CFP: 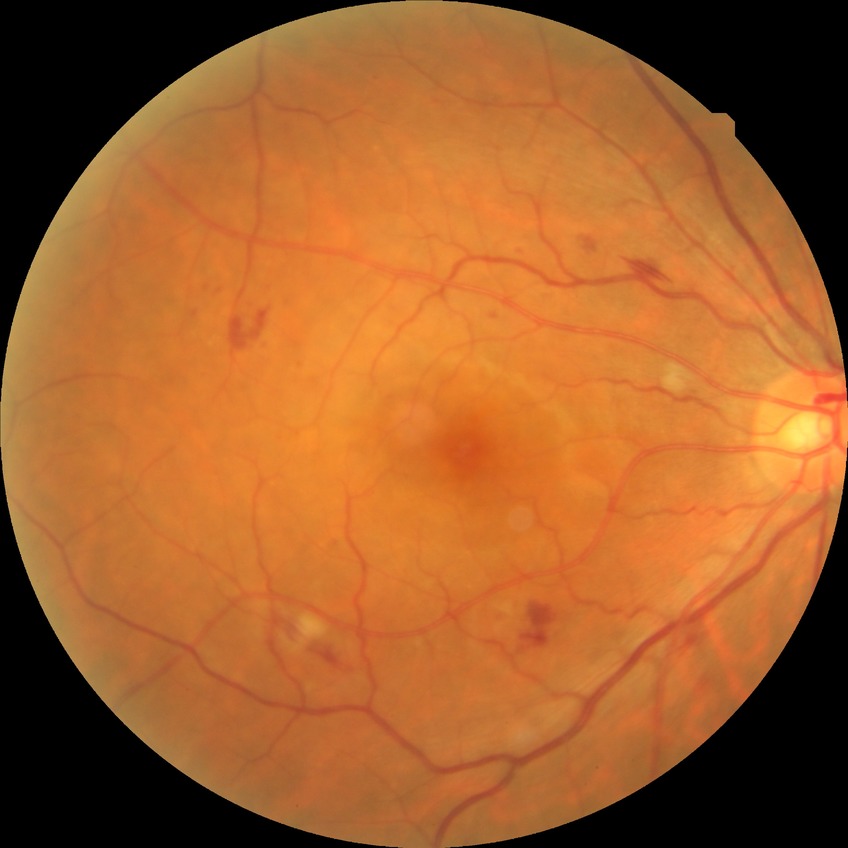

Diabetic retinopathy (DR) is simple diabetic retinopathy (SDR).